FOV: 45 degrees. Retinal fundus photograph — 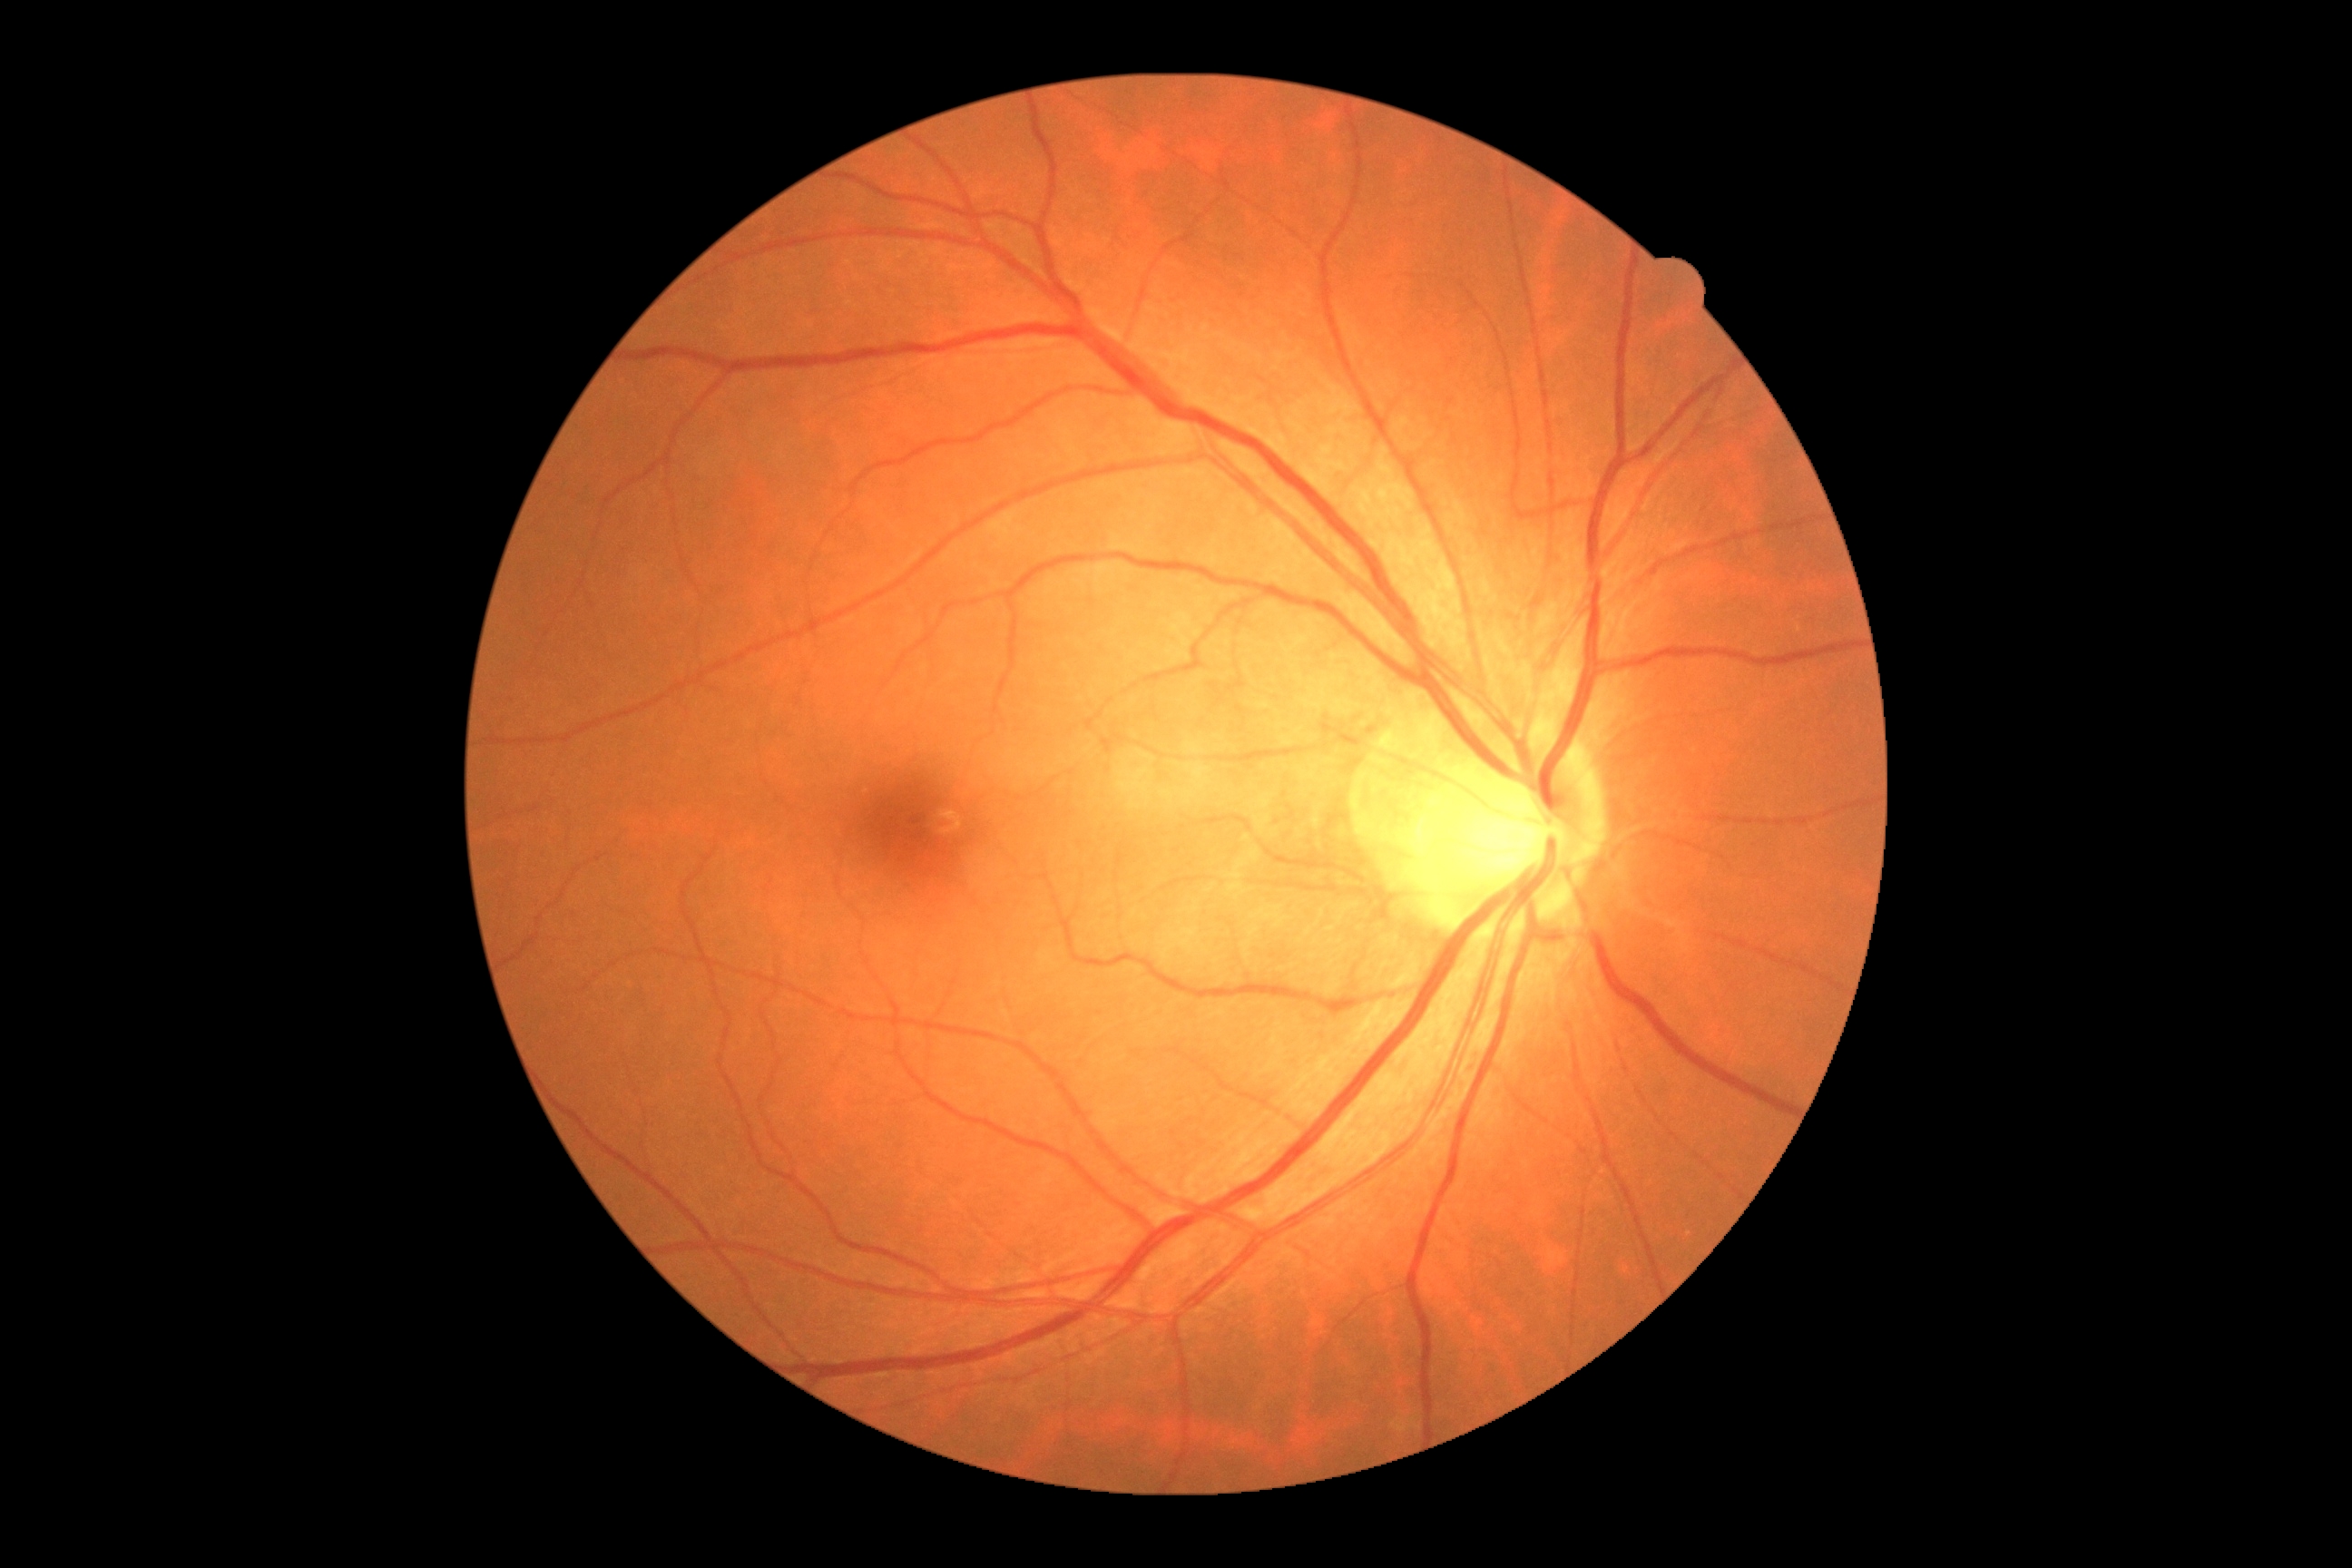

DR grade is 0.
No DR findings.